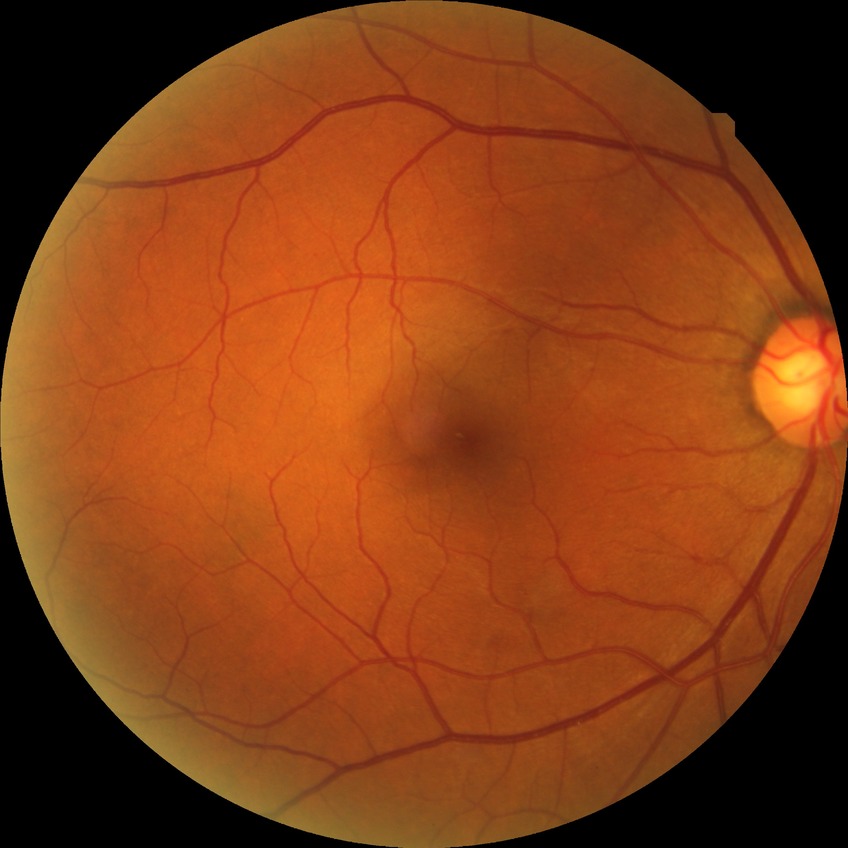

diabetic retinopathy (DR) = no diabetic retinopathy (NDR).